2352x1568; fundus photo:
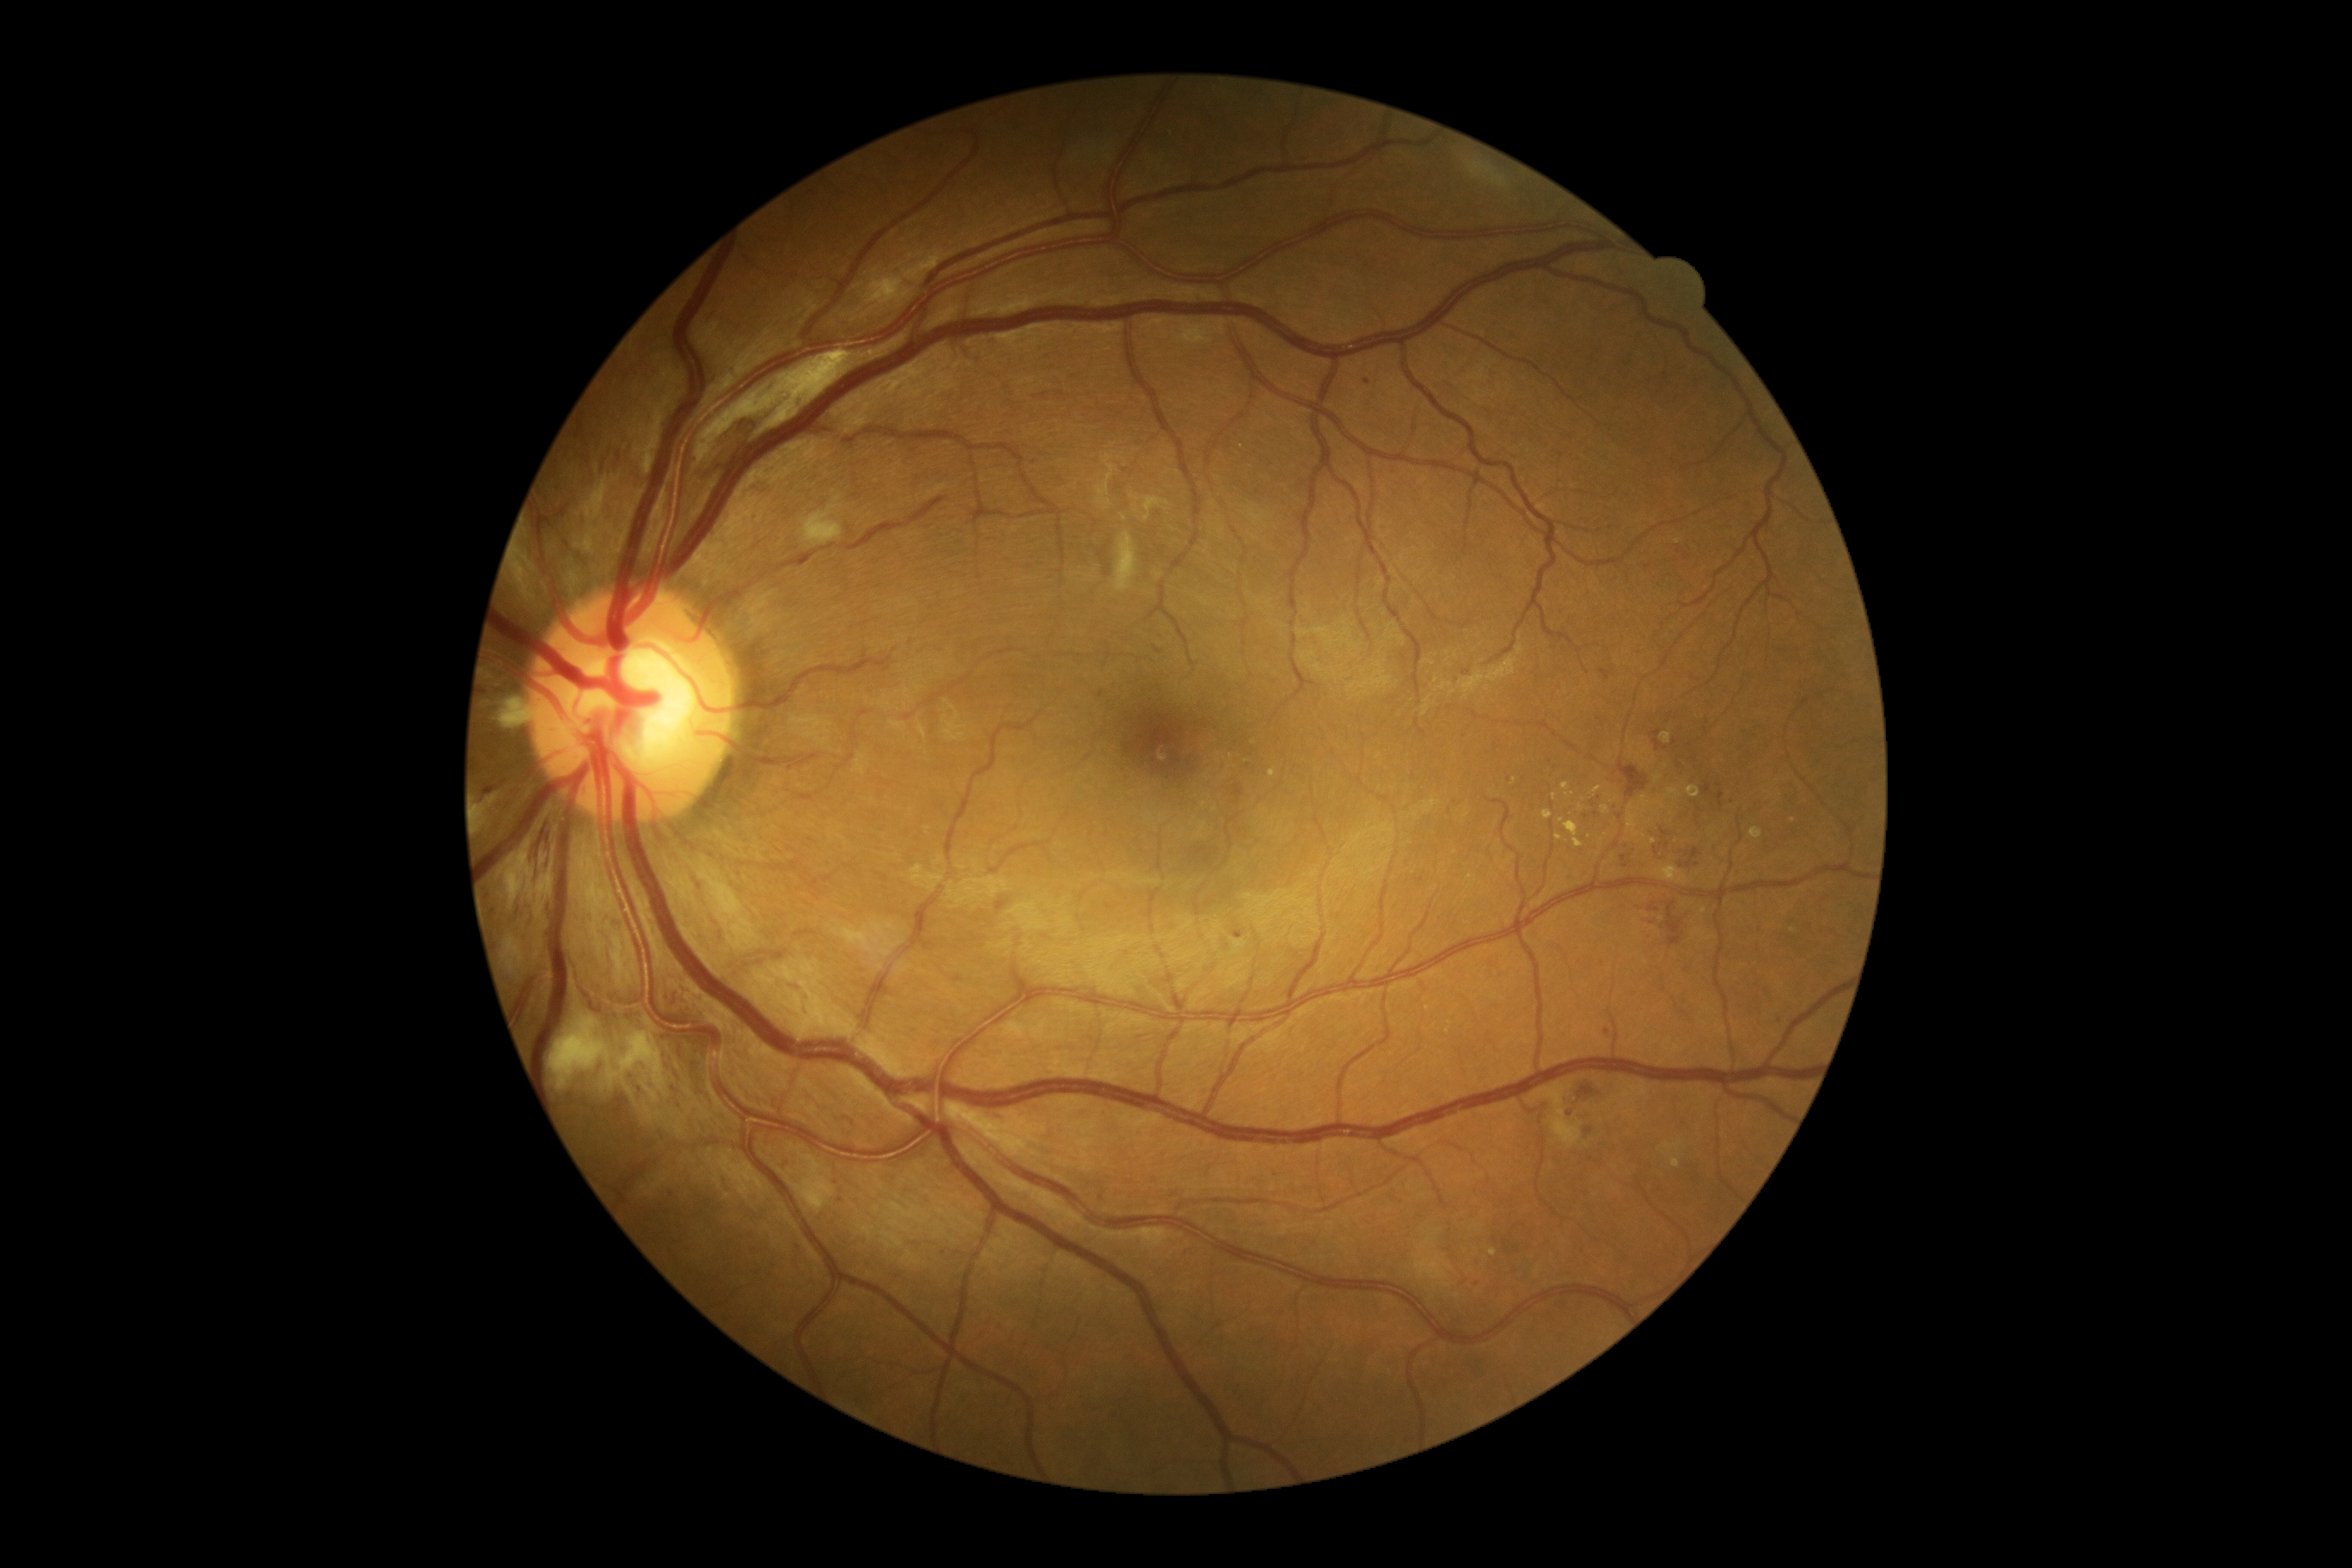

Diabetic retinopathy: grade 2
Lesions identified (partial list):
* hard exudates (more not shown): l=1749, t=828, r=1763, b=840 | l=1602, t=805, r=1610, b=816 | l=1560, t=818, r=1583, b=848 | l=1593, t=787, r=1602, b=795 | l=1555, t=835, r=1564, b=842
* Smaller hard exudates around (x=1794, y=931) | (x=1581, y=807) | (x=1678, y=542) | (x=1428, y=1008) | (x=1493, y=1252) | (x=1613, y=801) | (x=1793, y=820) | (x=1451, y=1023)
* microaneurysms (more not shown): l=993, t=340, r=1001, b=345 | l=1622, t=855, r=1627, b=867 | l=491, t=685, r=505, b=699 | l=1098, t=690, r=1105, b=699 | l=1514, t=333, r=1521, b=341 | l=558, t=508, r=567, b=517
* Smaller microaneurysms around (x=1589, y=1132) | (x=679, y=993) | (x=1599, y=798) | (x=1640, y=654) | (x=675, y=1089) | (x=1699, y=810) | (x=1614, y=806) | (x=677, y=1004) | (x=840, y=1201) | (x=1620, y=817) | (x=1583, y=1251) | (x=1367, y=382) | (x=1570, y=1115) | (x=1515, y=1249)
* hemorrhages: l=1655, t=738, r=1662, b=750 | l=1651, t=897, r=1684, b=946 | l=1234, t=785, r=1244, b=805 | l=1675, t=845, r=1705, b=871 | l=1600, t=670, r=1610, b=682 | l=995, t=902, r=1007, b=910 | l=1577, t=1084, r=1595, b=1099 | l=1617, t=764, r=1648, b=799 | l=1651, t=730, r=1660, b=737 | l=1646, t=828, r=1675, b=859 | l=529, t=826, r=553, b=888
* soft exudates (more not shown): l=864, t=250, r=959, b=305 | l=1144, t=317, r=1228, b=346 | l=630, t=398, r=671, b=475 | l=1096, t=455, r=1118, b=510 | l=1144, t=496, r=1170, b=522 | l=1113, t=532, r=1139, b=592 | l=567, t=565, r=577, b=592 | l=505, t=869, r=525, b=910 | l=1130, t=494, r=1141, b=501 | l=695, t=350, r=852, b=465 | l=1466, t=161, r=1507, b=188
* Smaller soft exudates around (x=1124, y=519) | (x=1113, y=444)